45-degree field of view, CFP, image size 2352x1568:
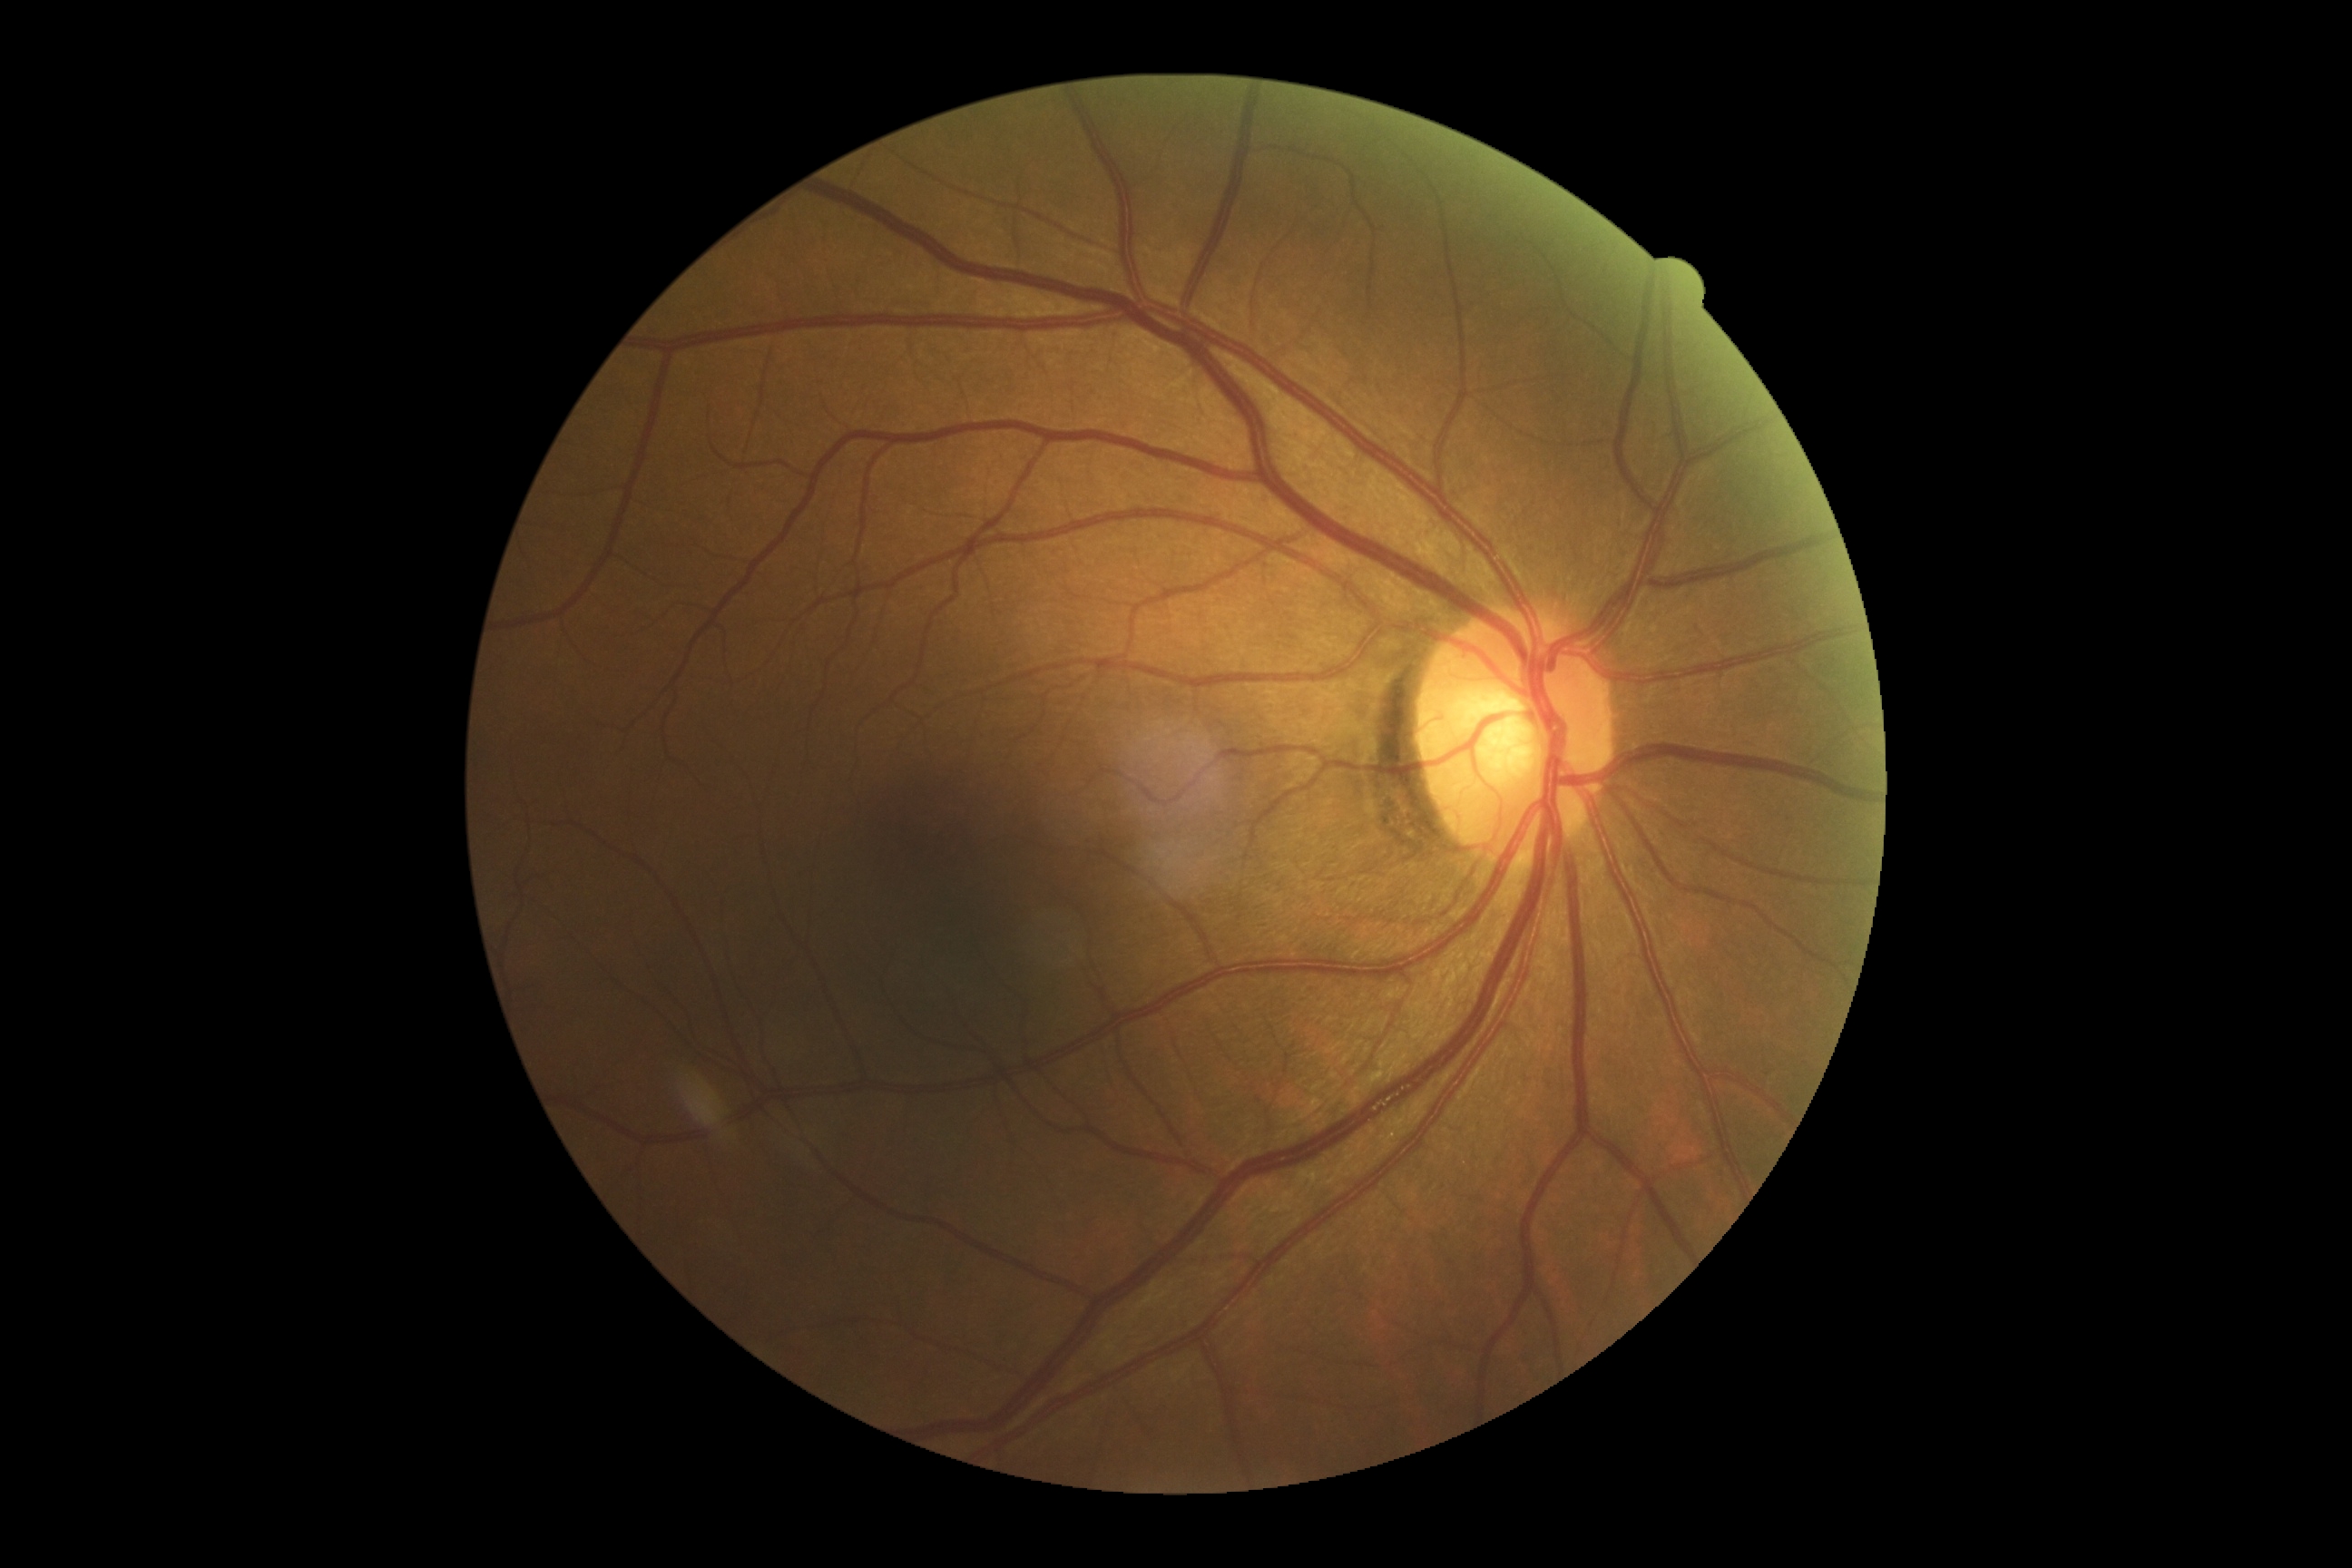 Diabetic retinopathy severity is grade 0 (no apparent retinopathy). No DR findings.